Infant wide-field retinal image — 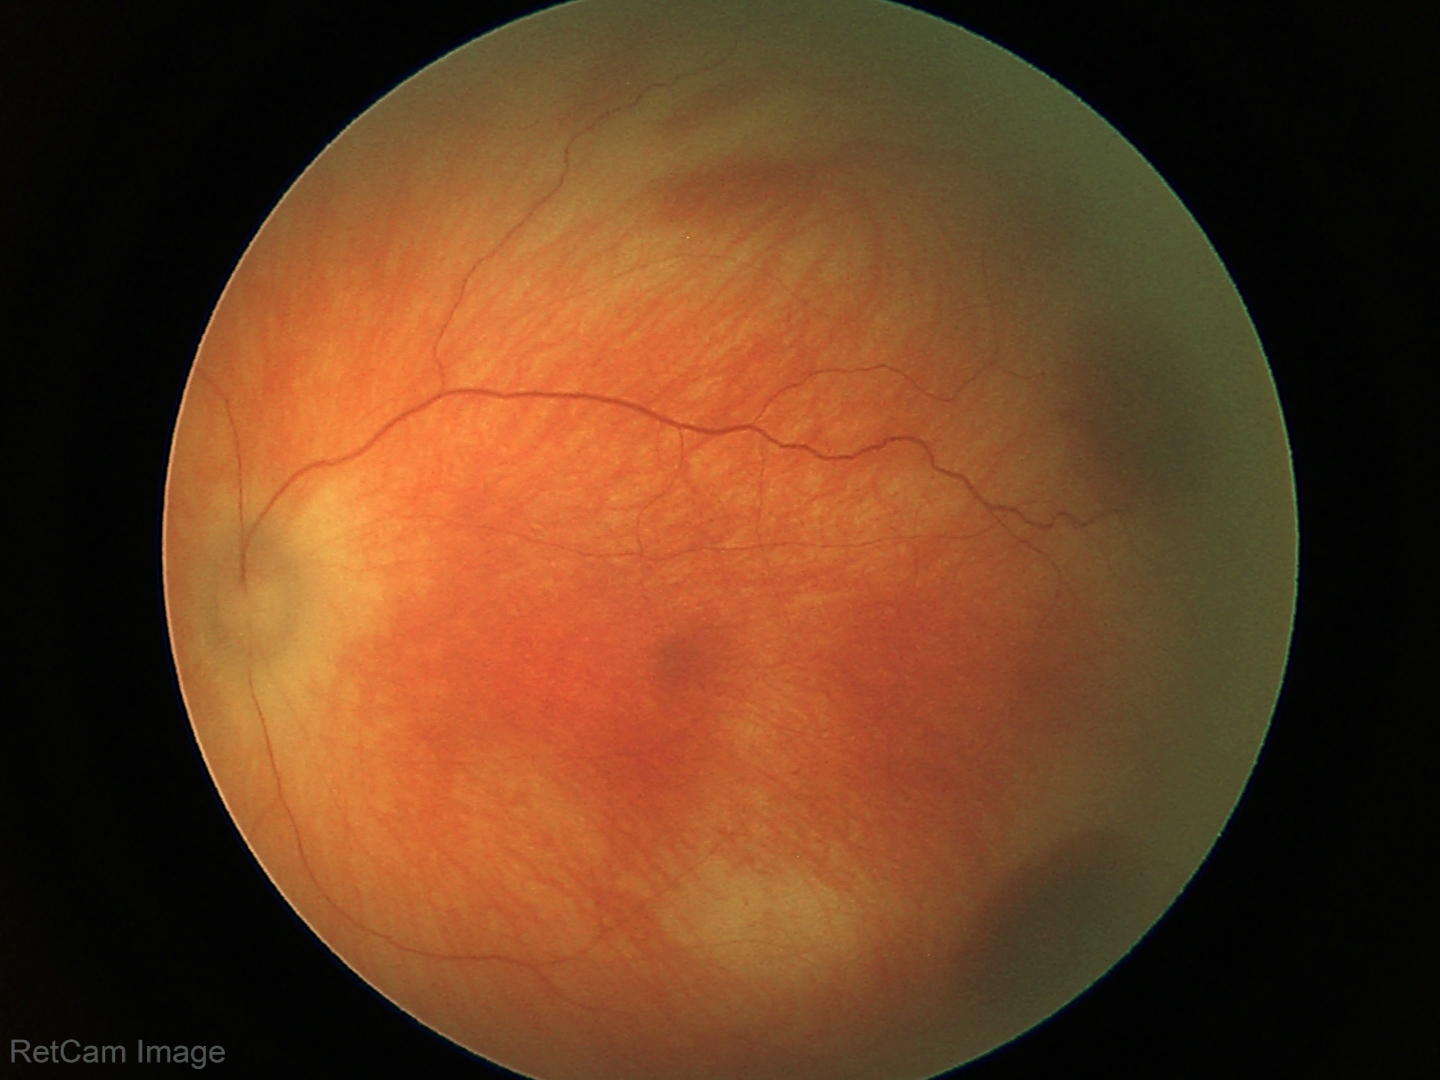 Screening diagnosis = retinal hemorrhages.